45° FOV — 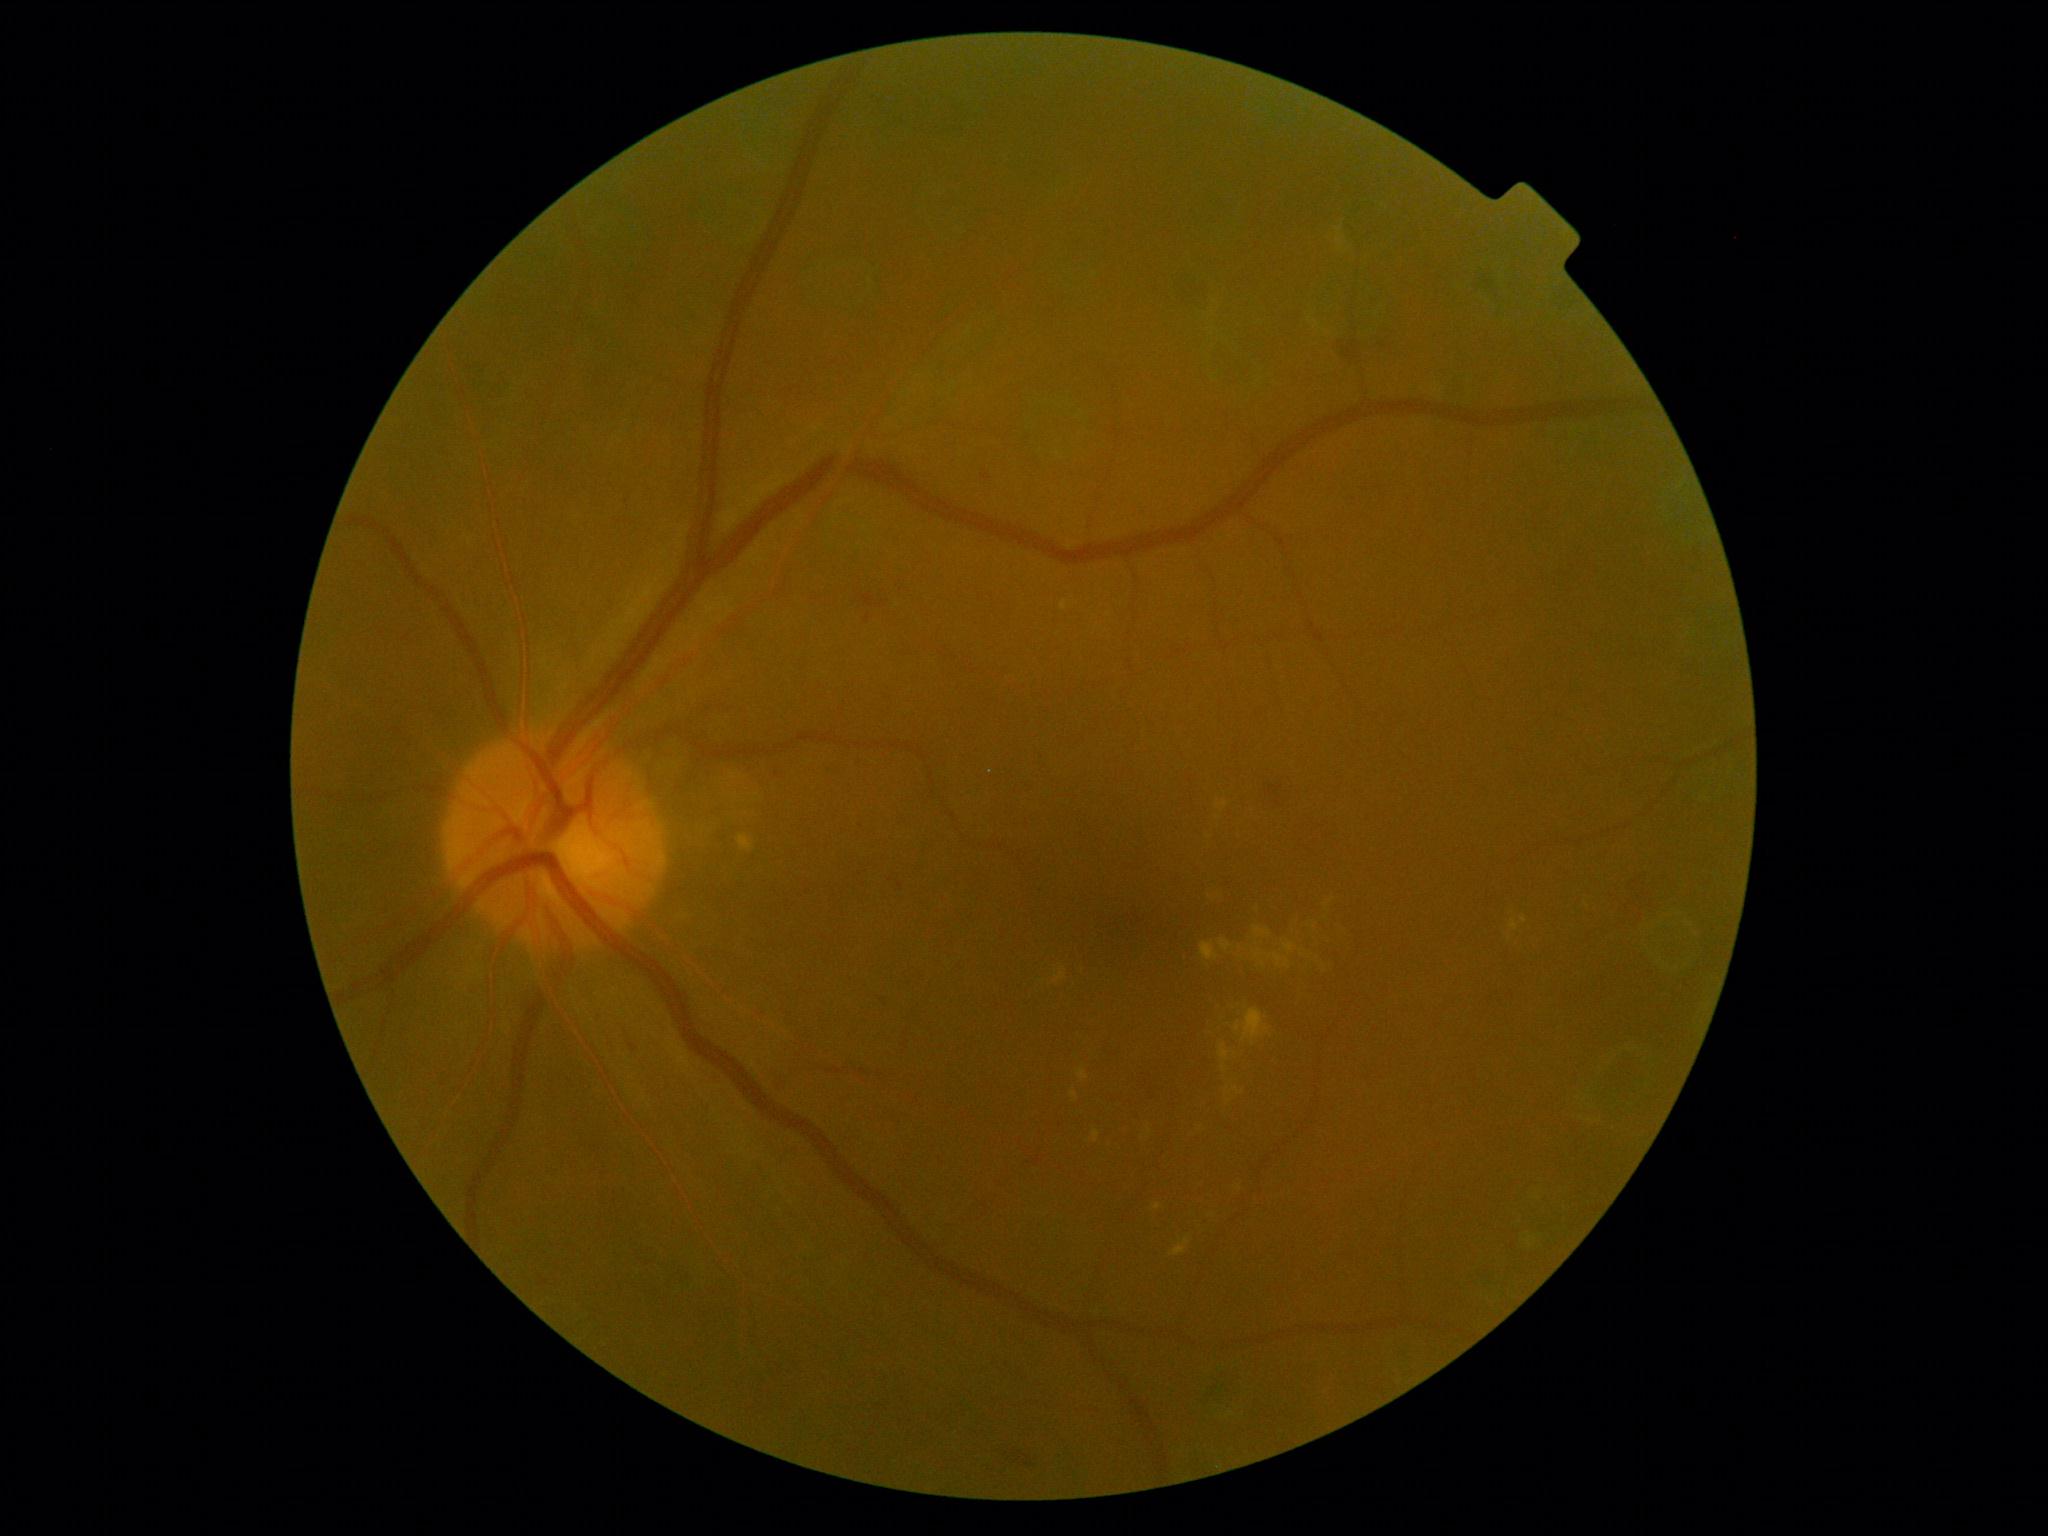
The retinopathy is classified as non-proliferative diabetic retinopathy. DR is grade 2 (moderate NPDR).